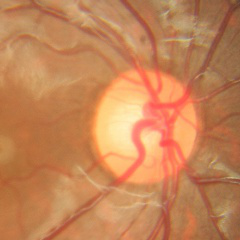

The image shows no glaucomatous optic neuropathy.